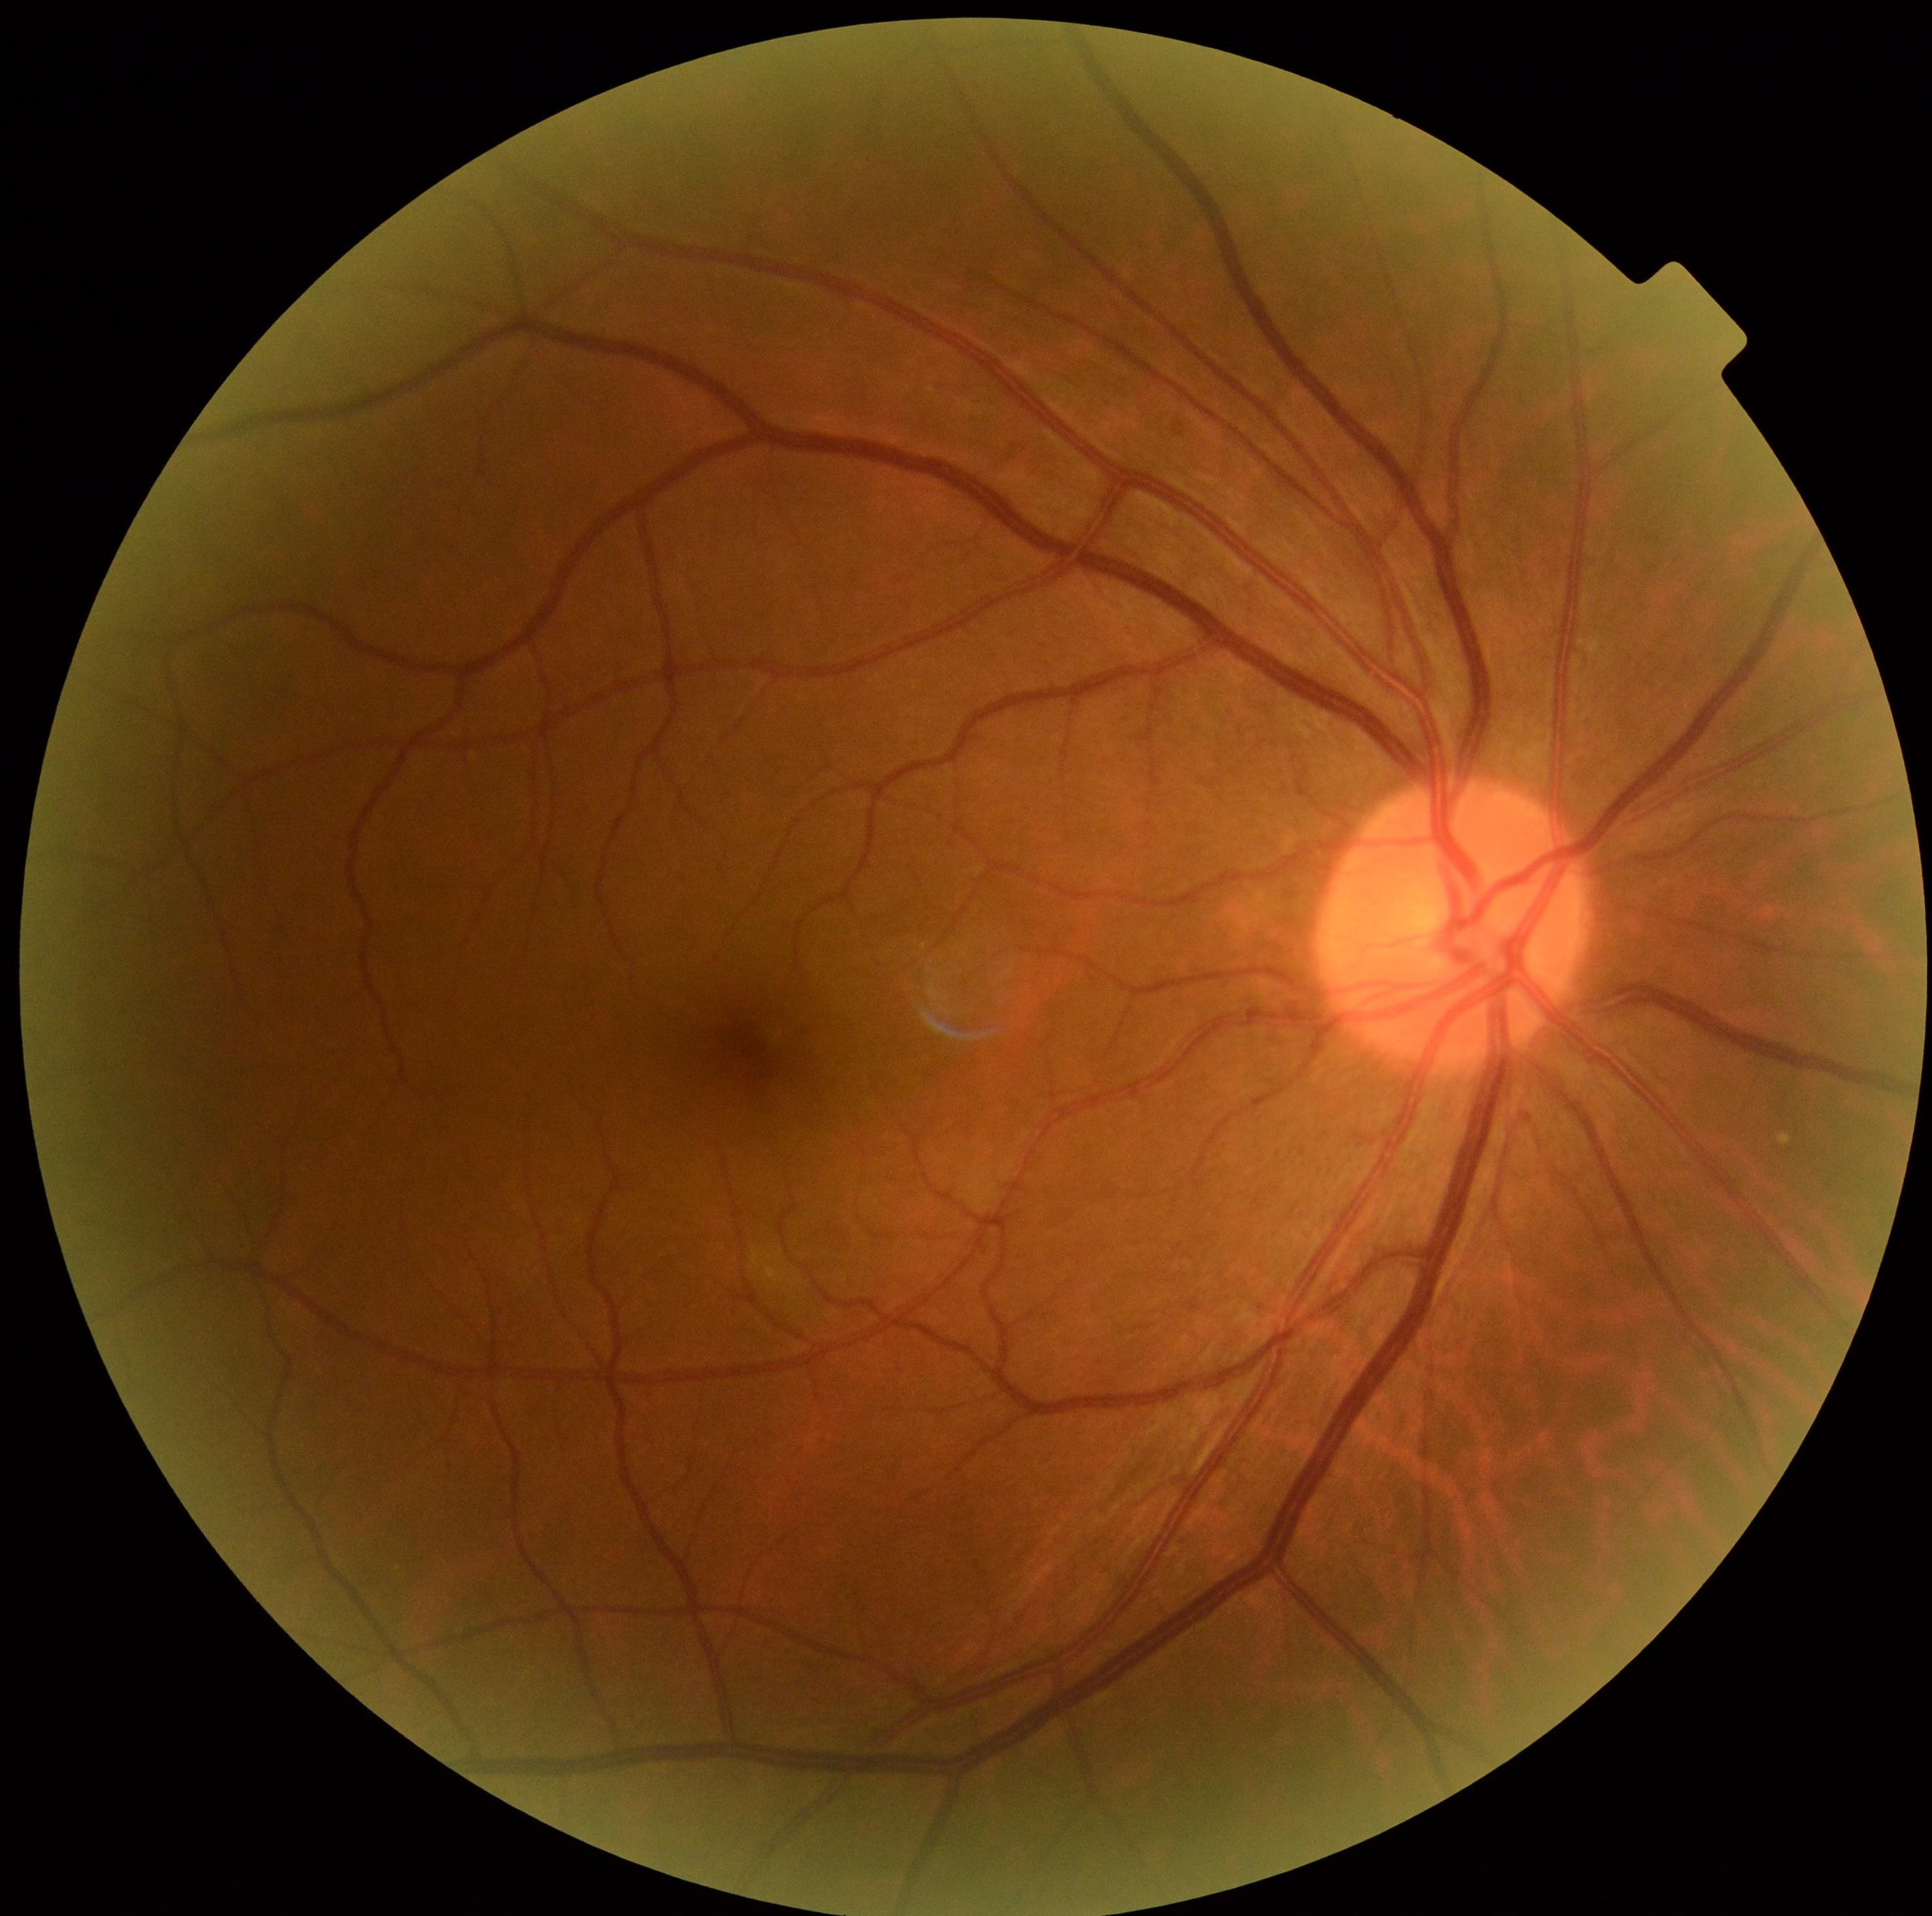
DR stage: no apparent retinopathy (grade 0).